DR severity per modified Davis staging
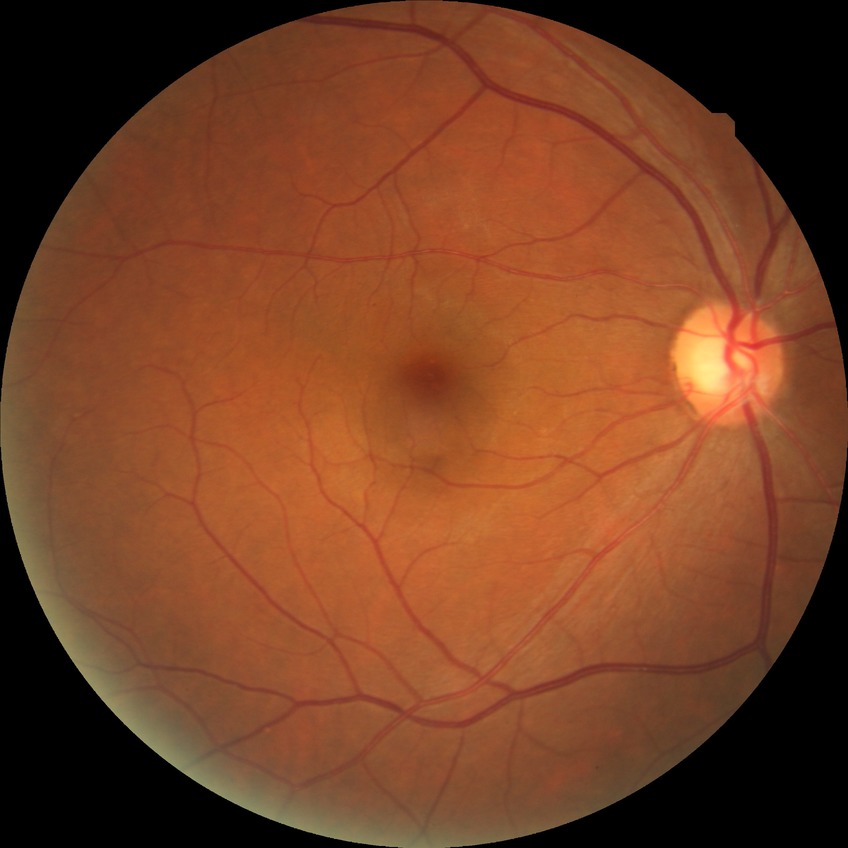
diabetic retinopathy (DR) = no diabetic retinopathy (NDR).